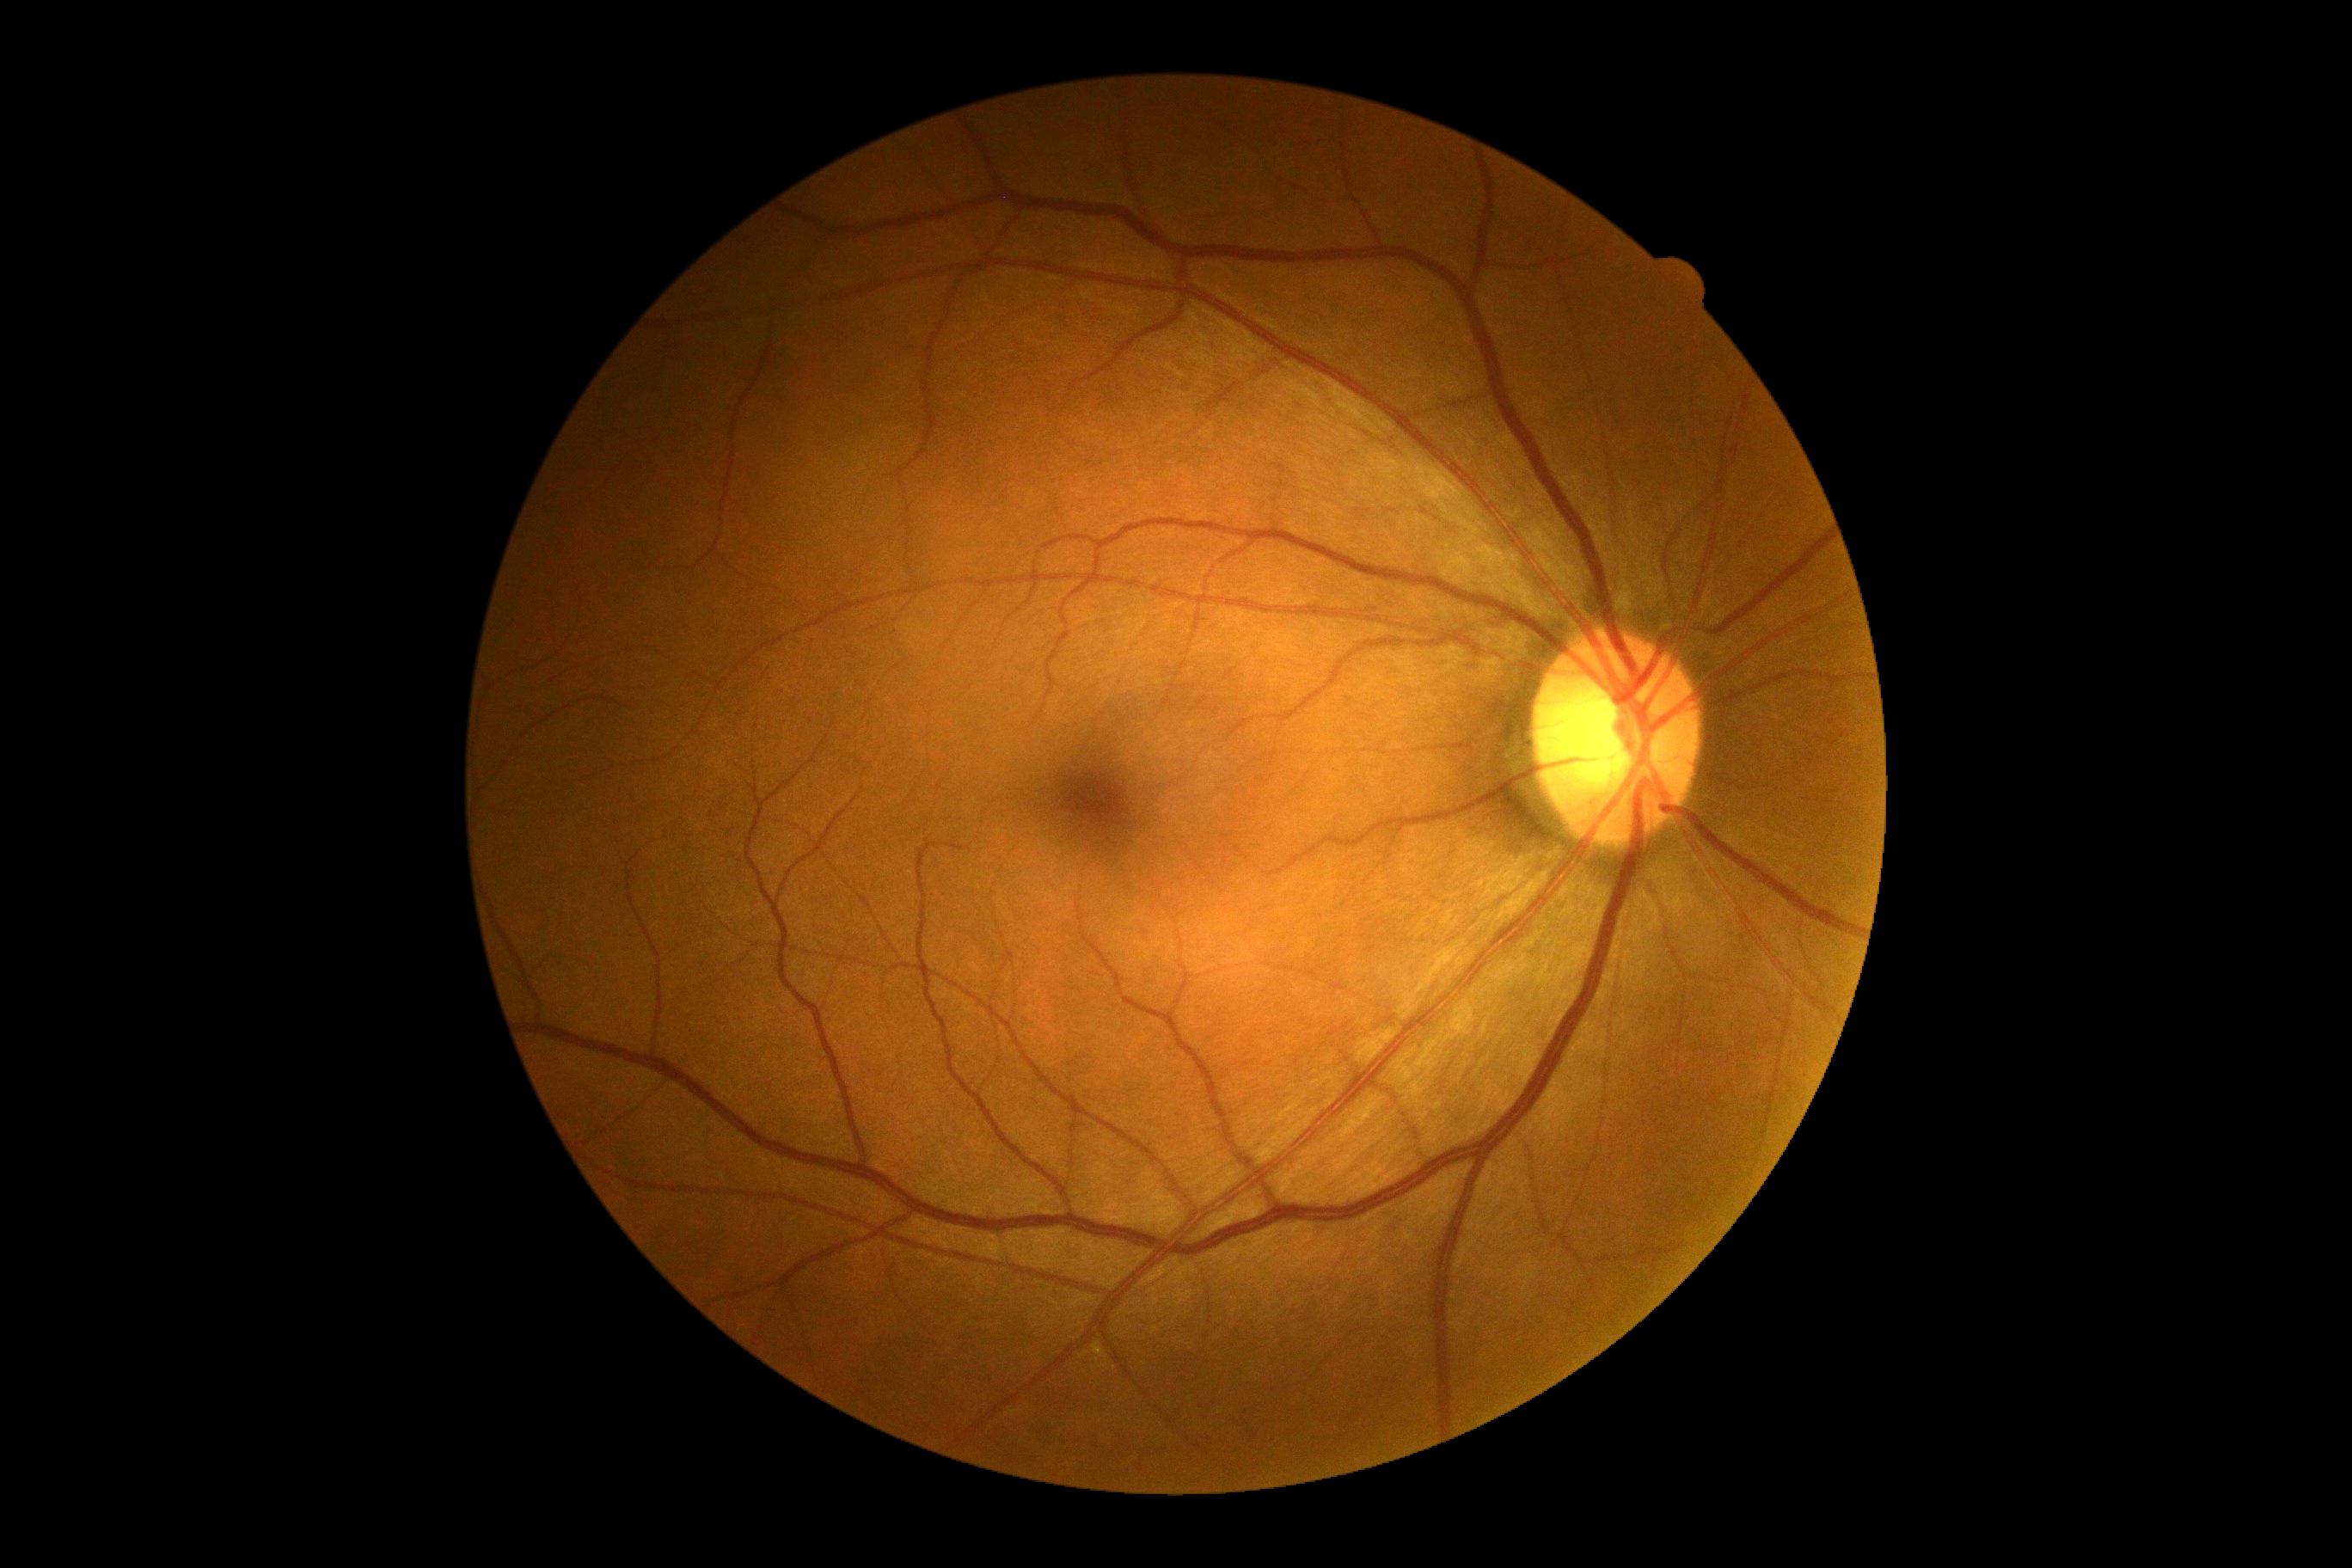 No signs of diabetic retinopathy.
Retinopathy is grade 0.